Image size 1725x1721 · retinal fundus photograph · 45-degree field of view.
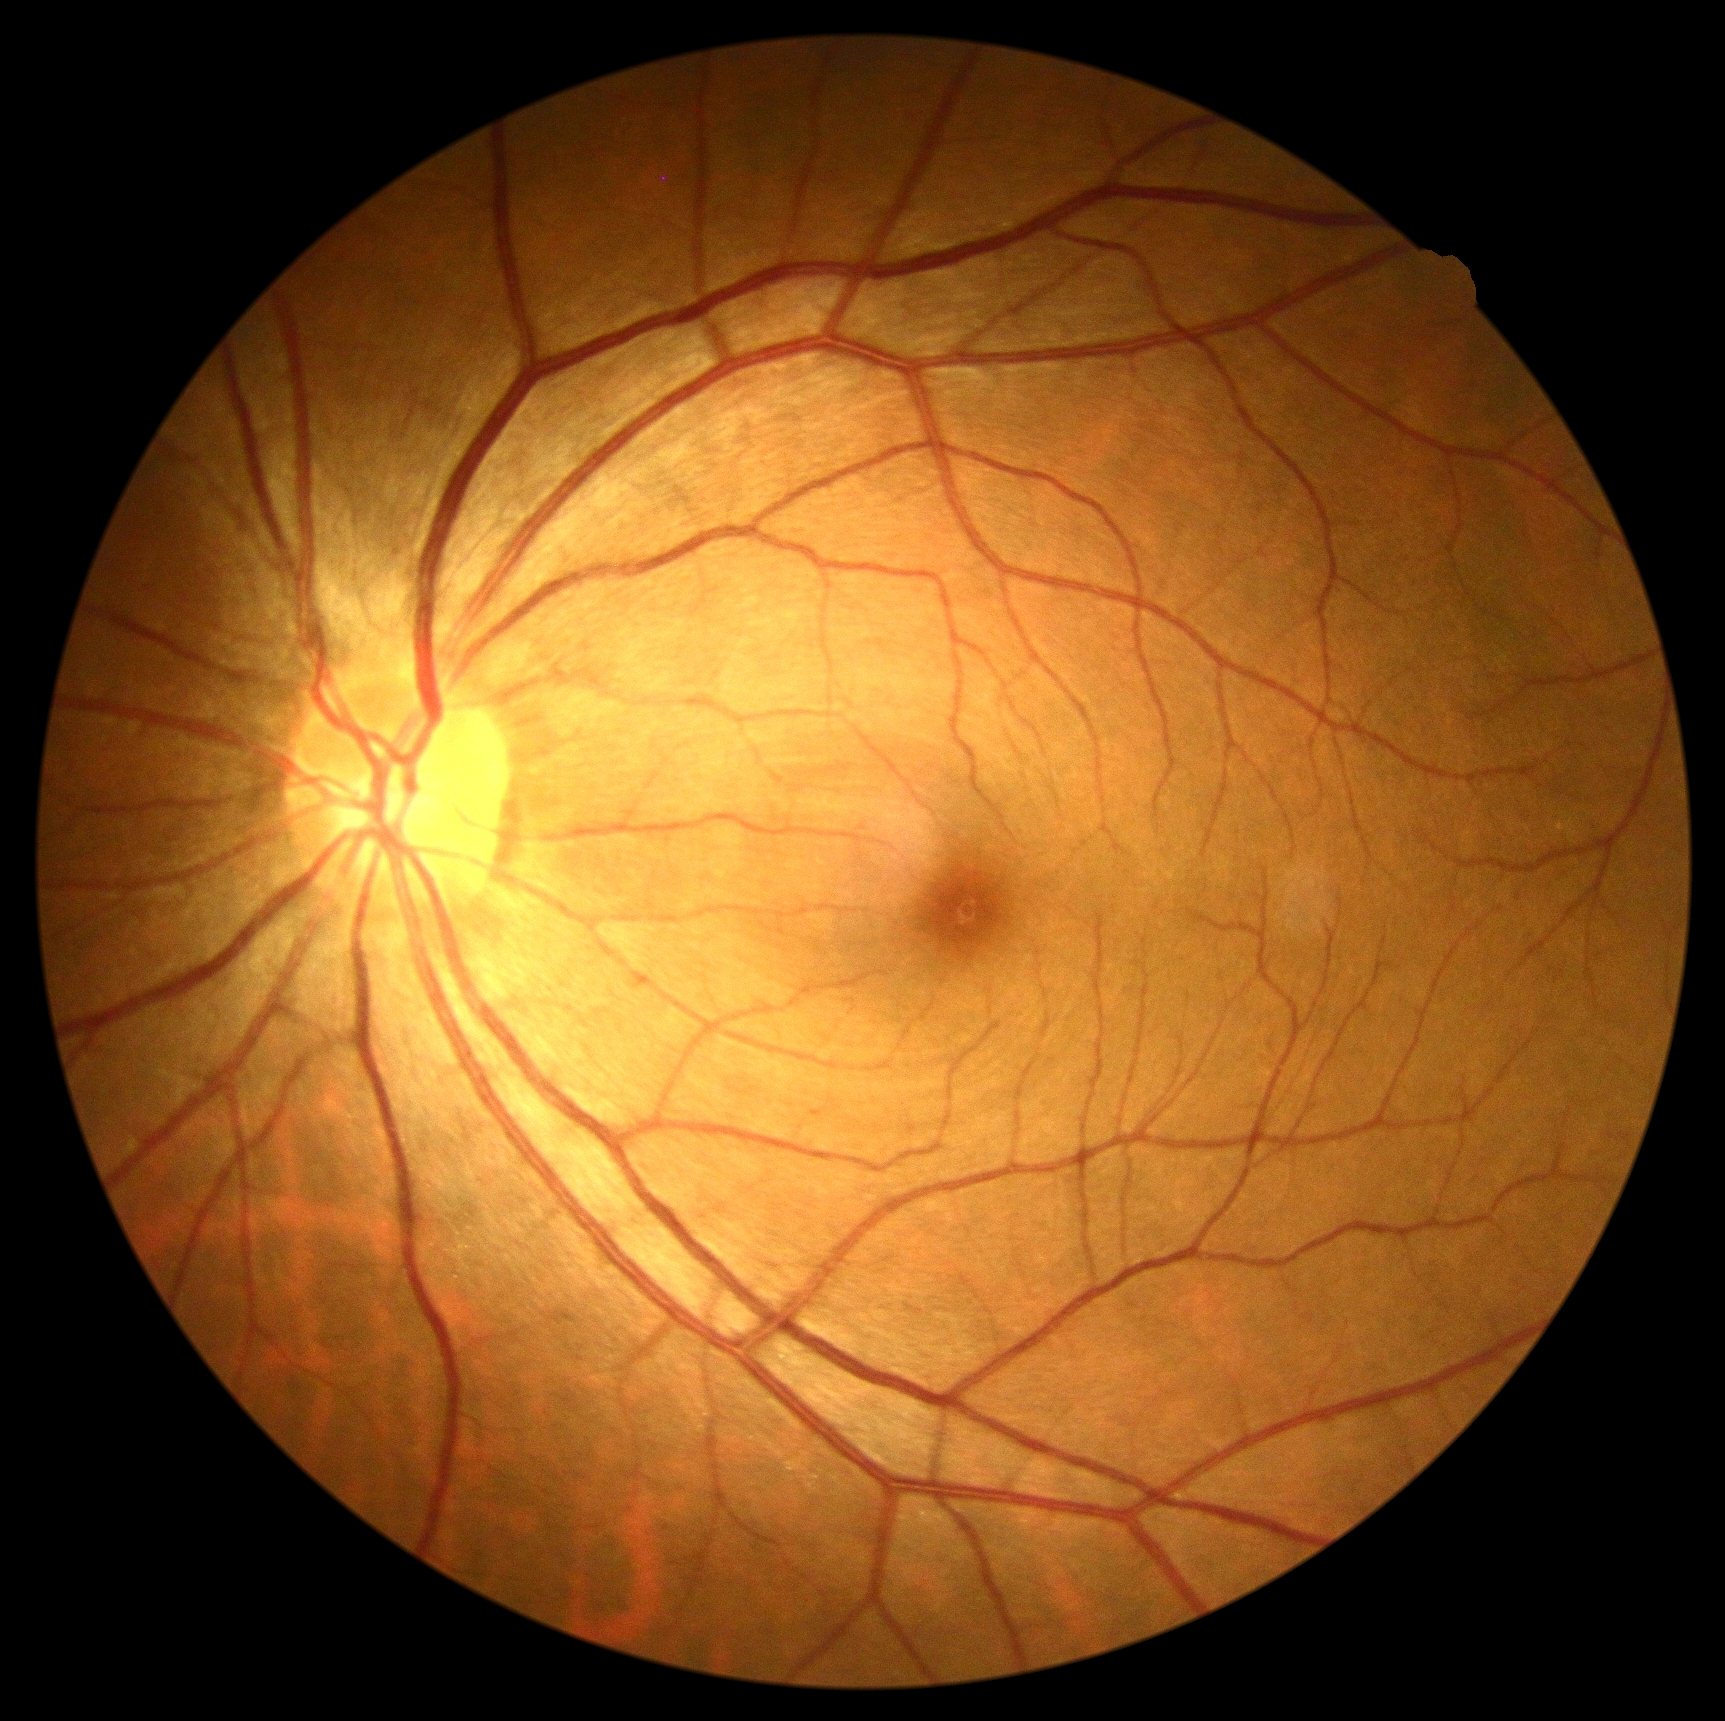

Retinopathy grade is 0 (no apparent retinopathy).